Optic disc-centered crop from a color fundus photograph. Cropped from a 35-degree field of view:
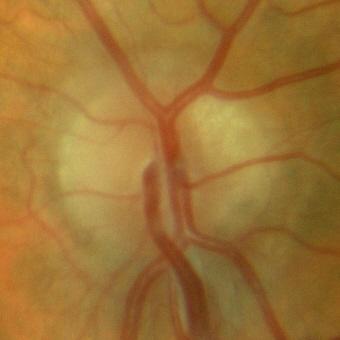
Diagnosis: no glaucomatous optic neuropathy.